Acquired on the Clarity RetCam 3 · infant wide-field fundus photograph · image size 640x480
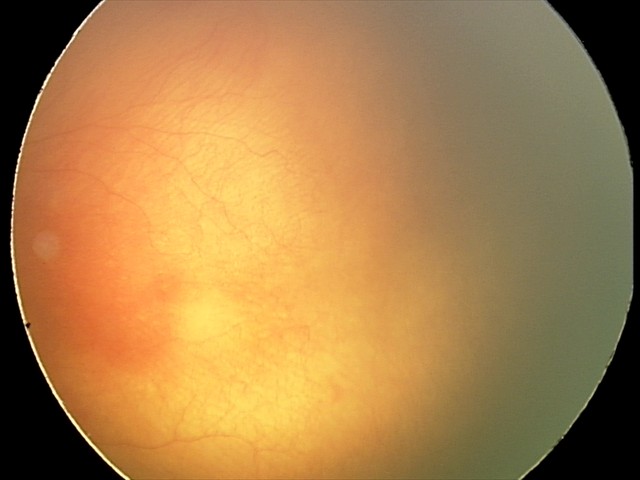

Diagnosis from this screening exam: aggressive ROP (A-ROP).